1240 x 1240 pixels; wide-field fundus image from infant ROP screening
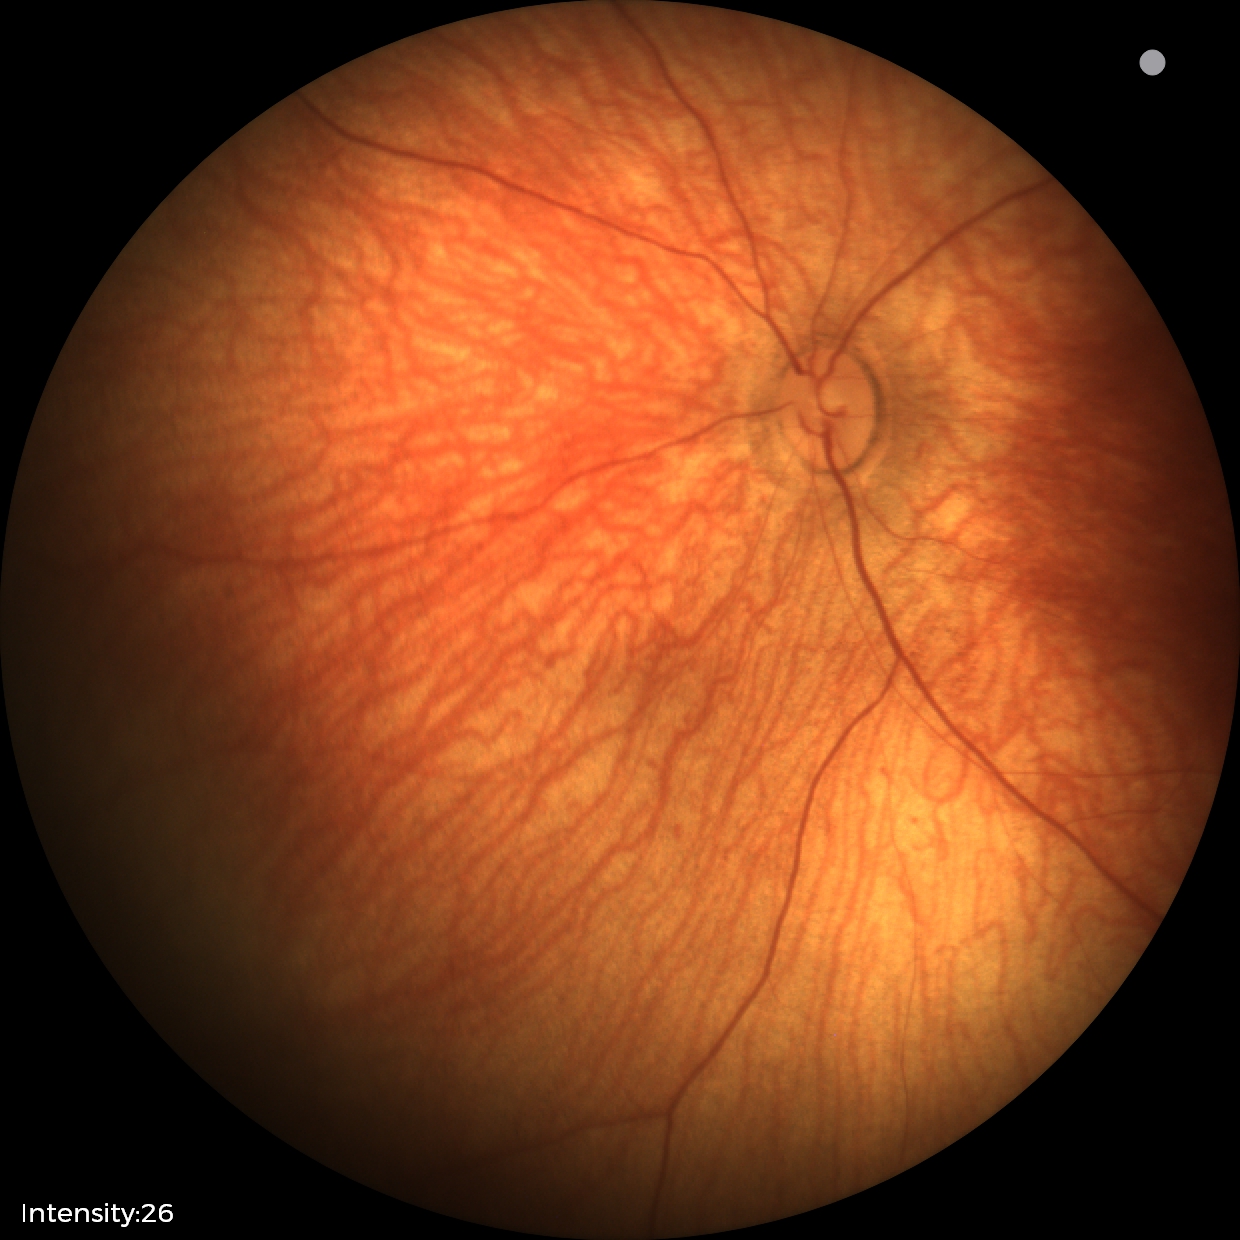

No retinal pathology identified on screening.